Captured with the Clarity RetCam 3 (130° field of view) · wide-field fundus photograph from neonatal ROP screening · 640x480
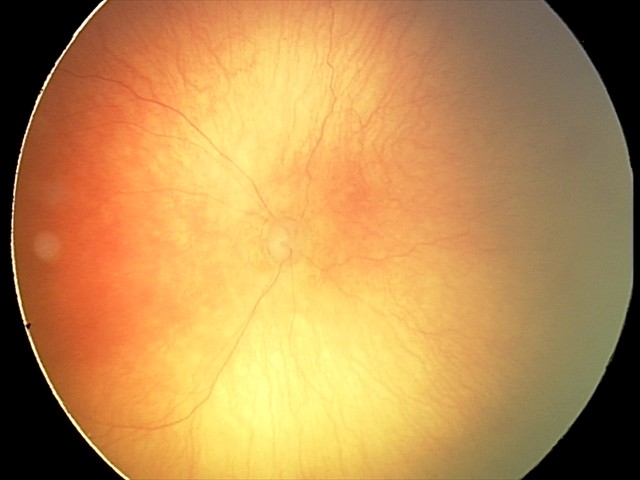
Plus disease present.
Screening examination consistent with aggressive retinopathy of prematurity (A-ROP).